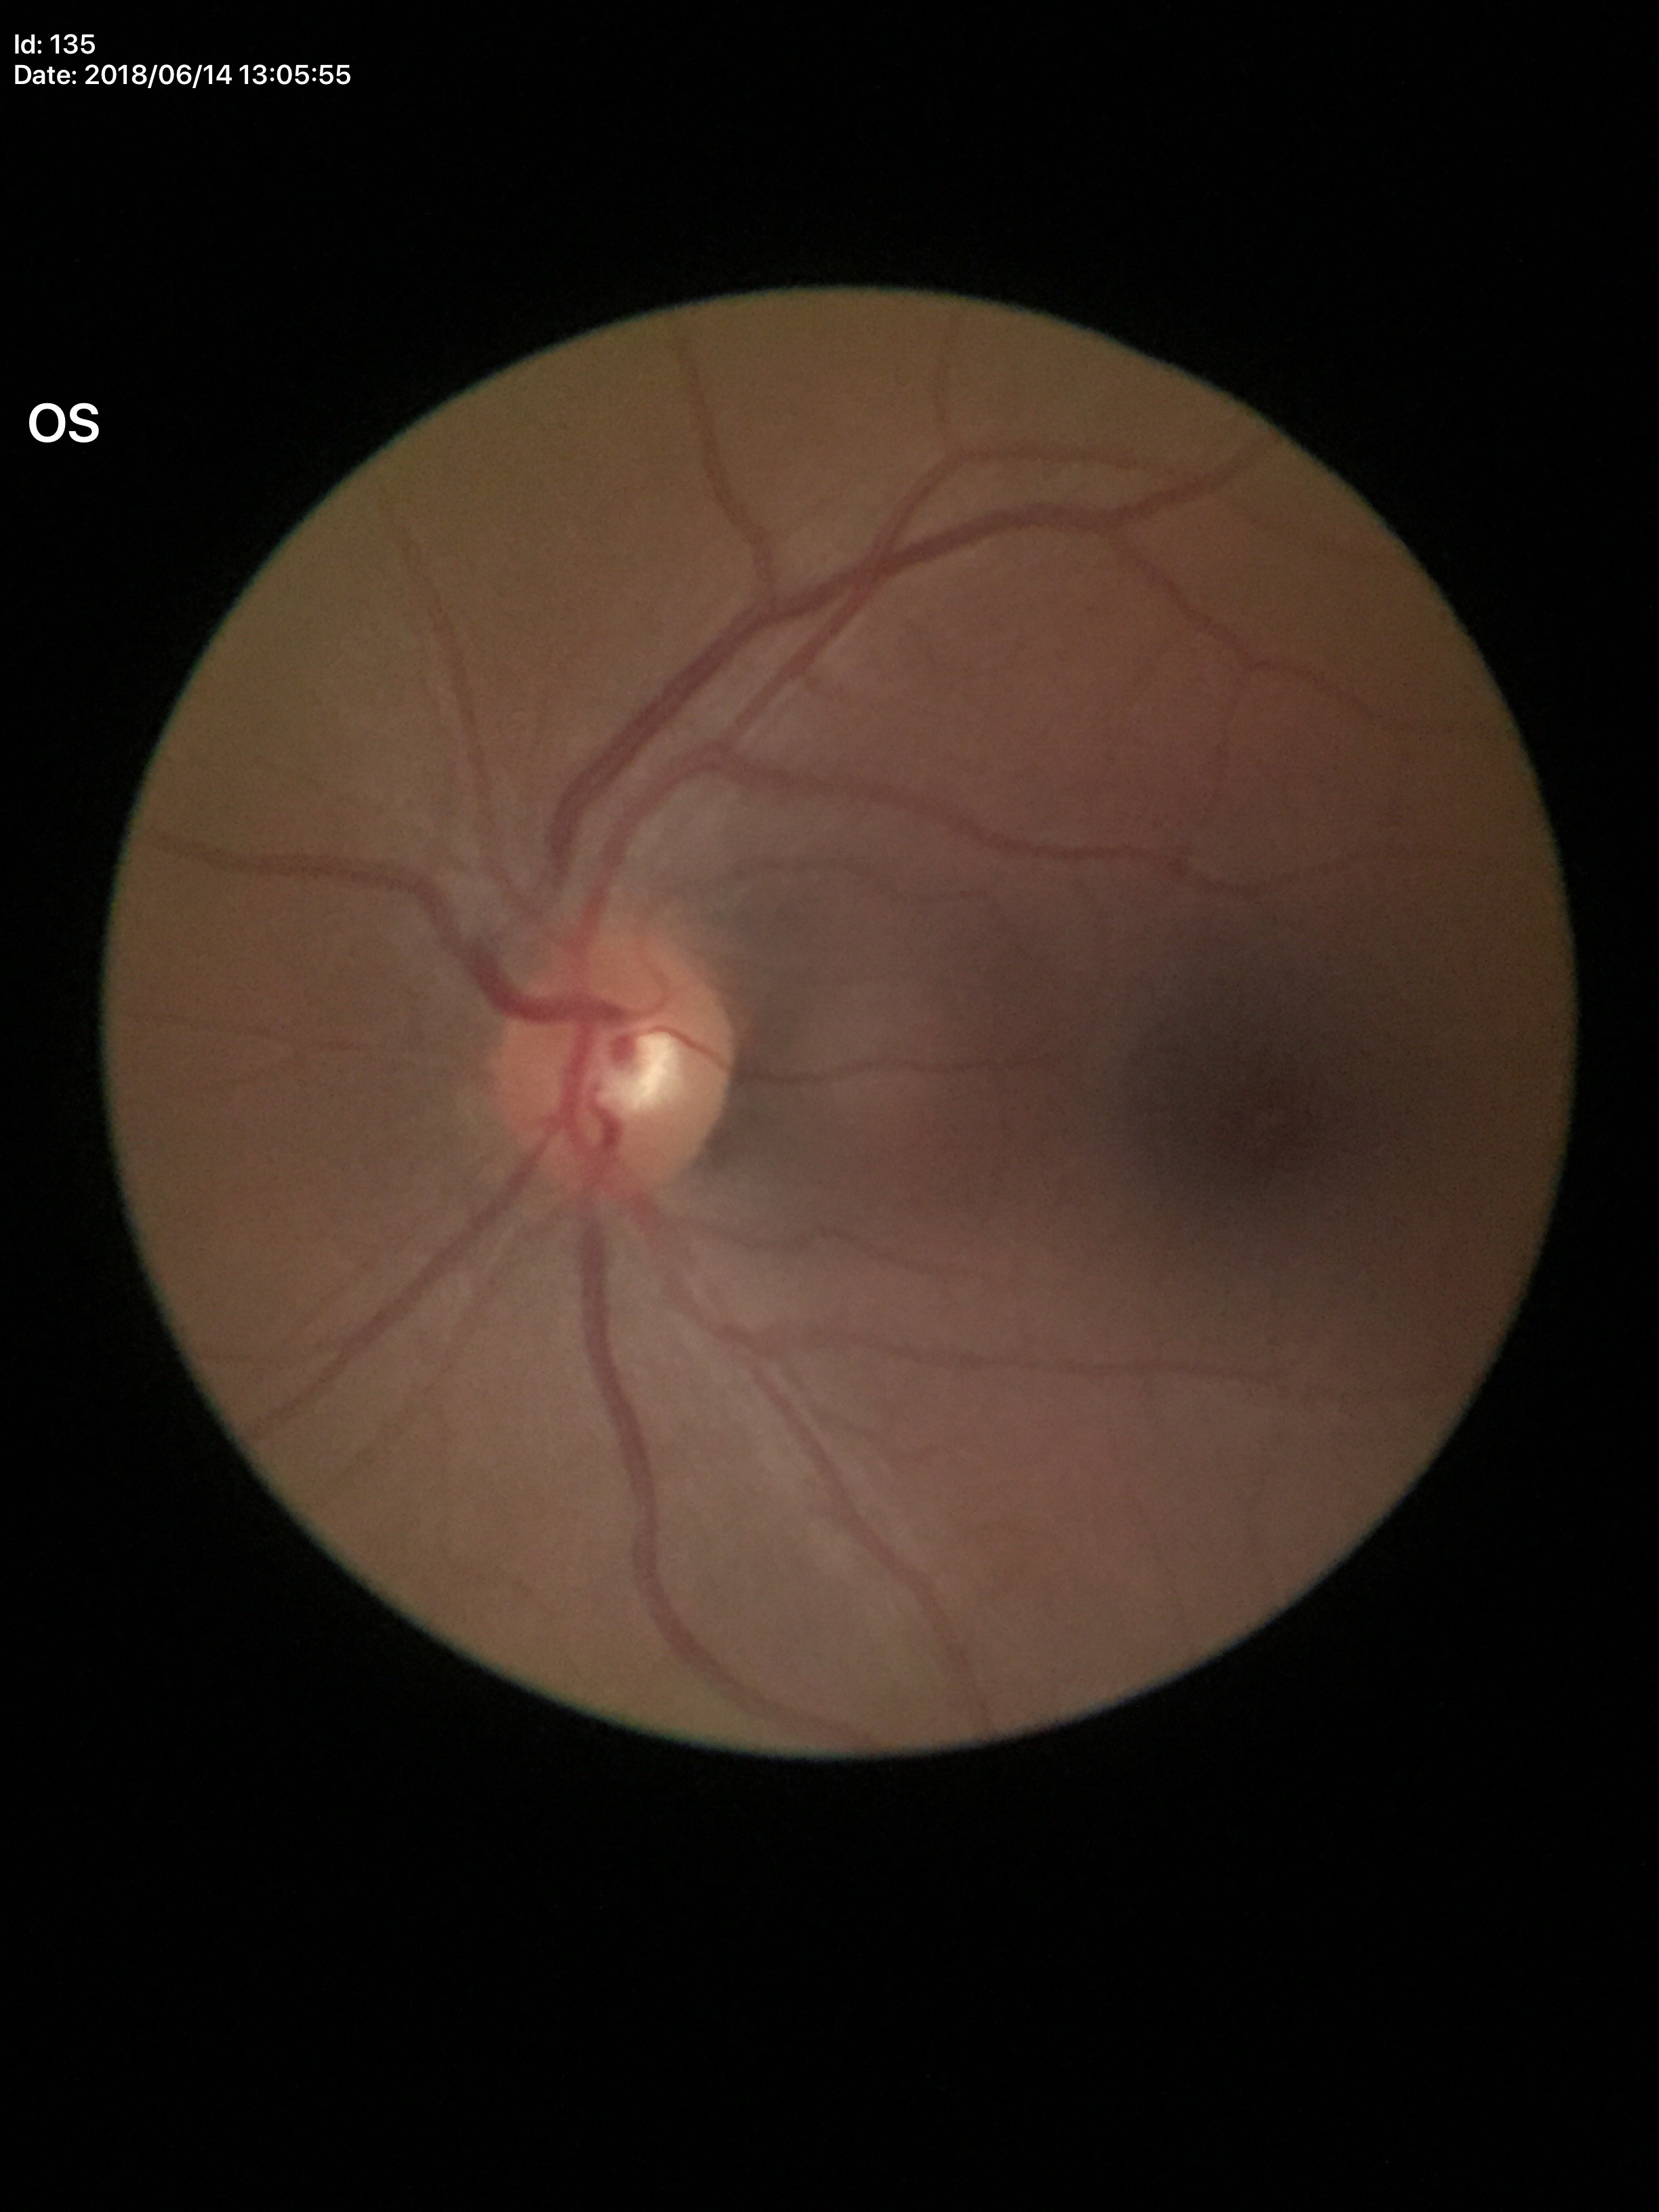

HCDR: 0.50; Glaucoma impression: negative; VCDR: 0.44.